Color fundus photograph · 2352 by 1568 pixels
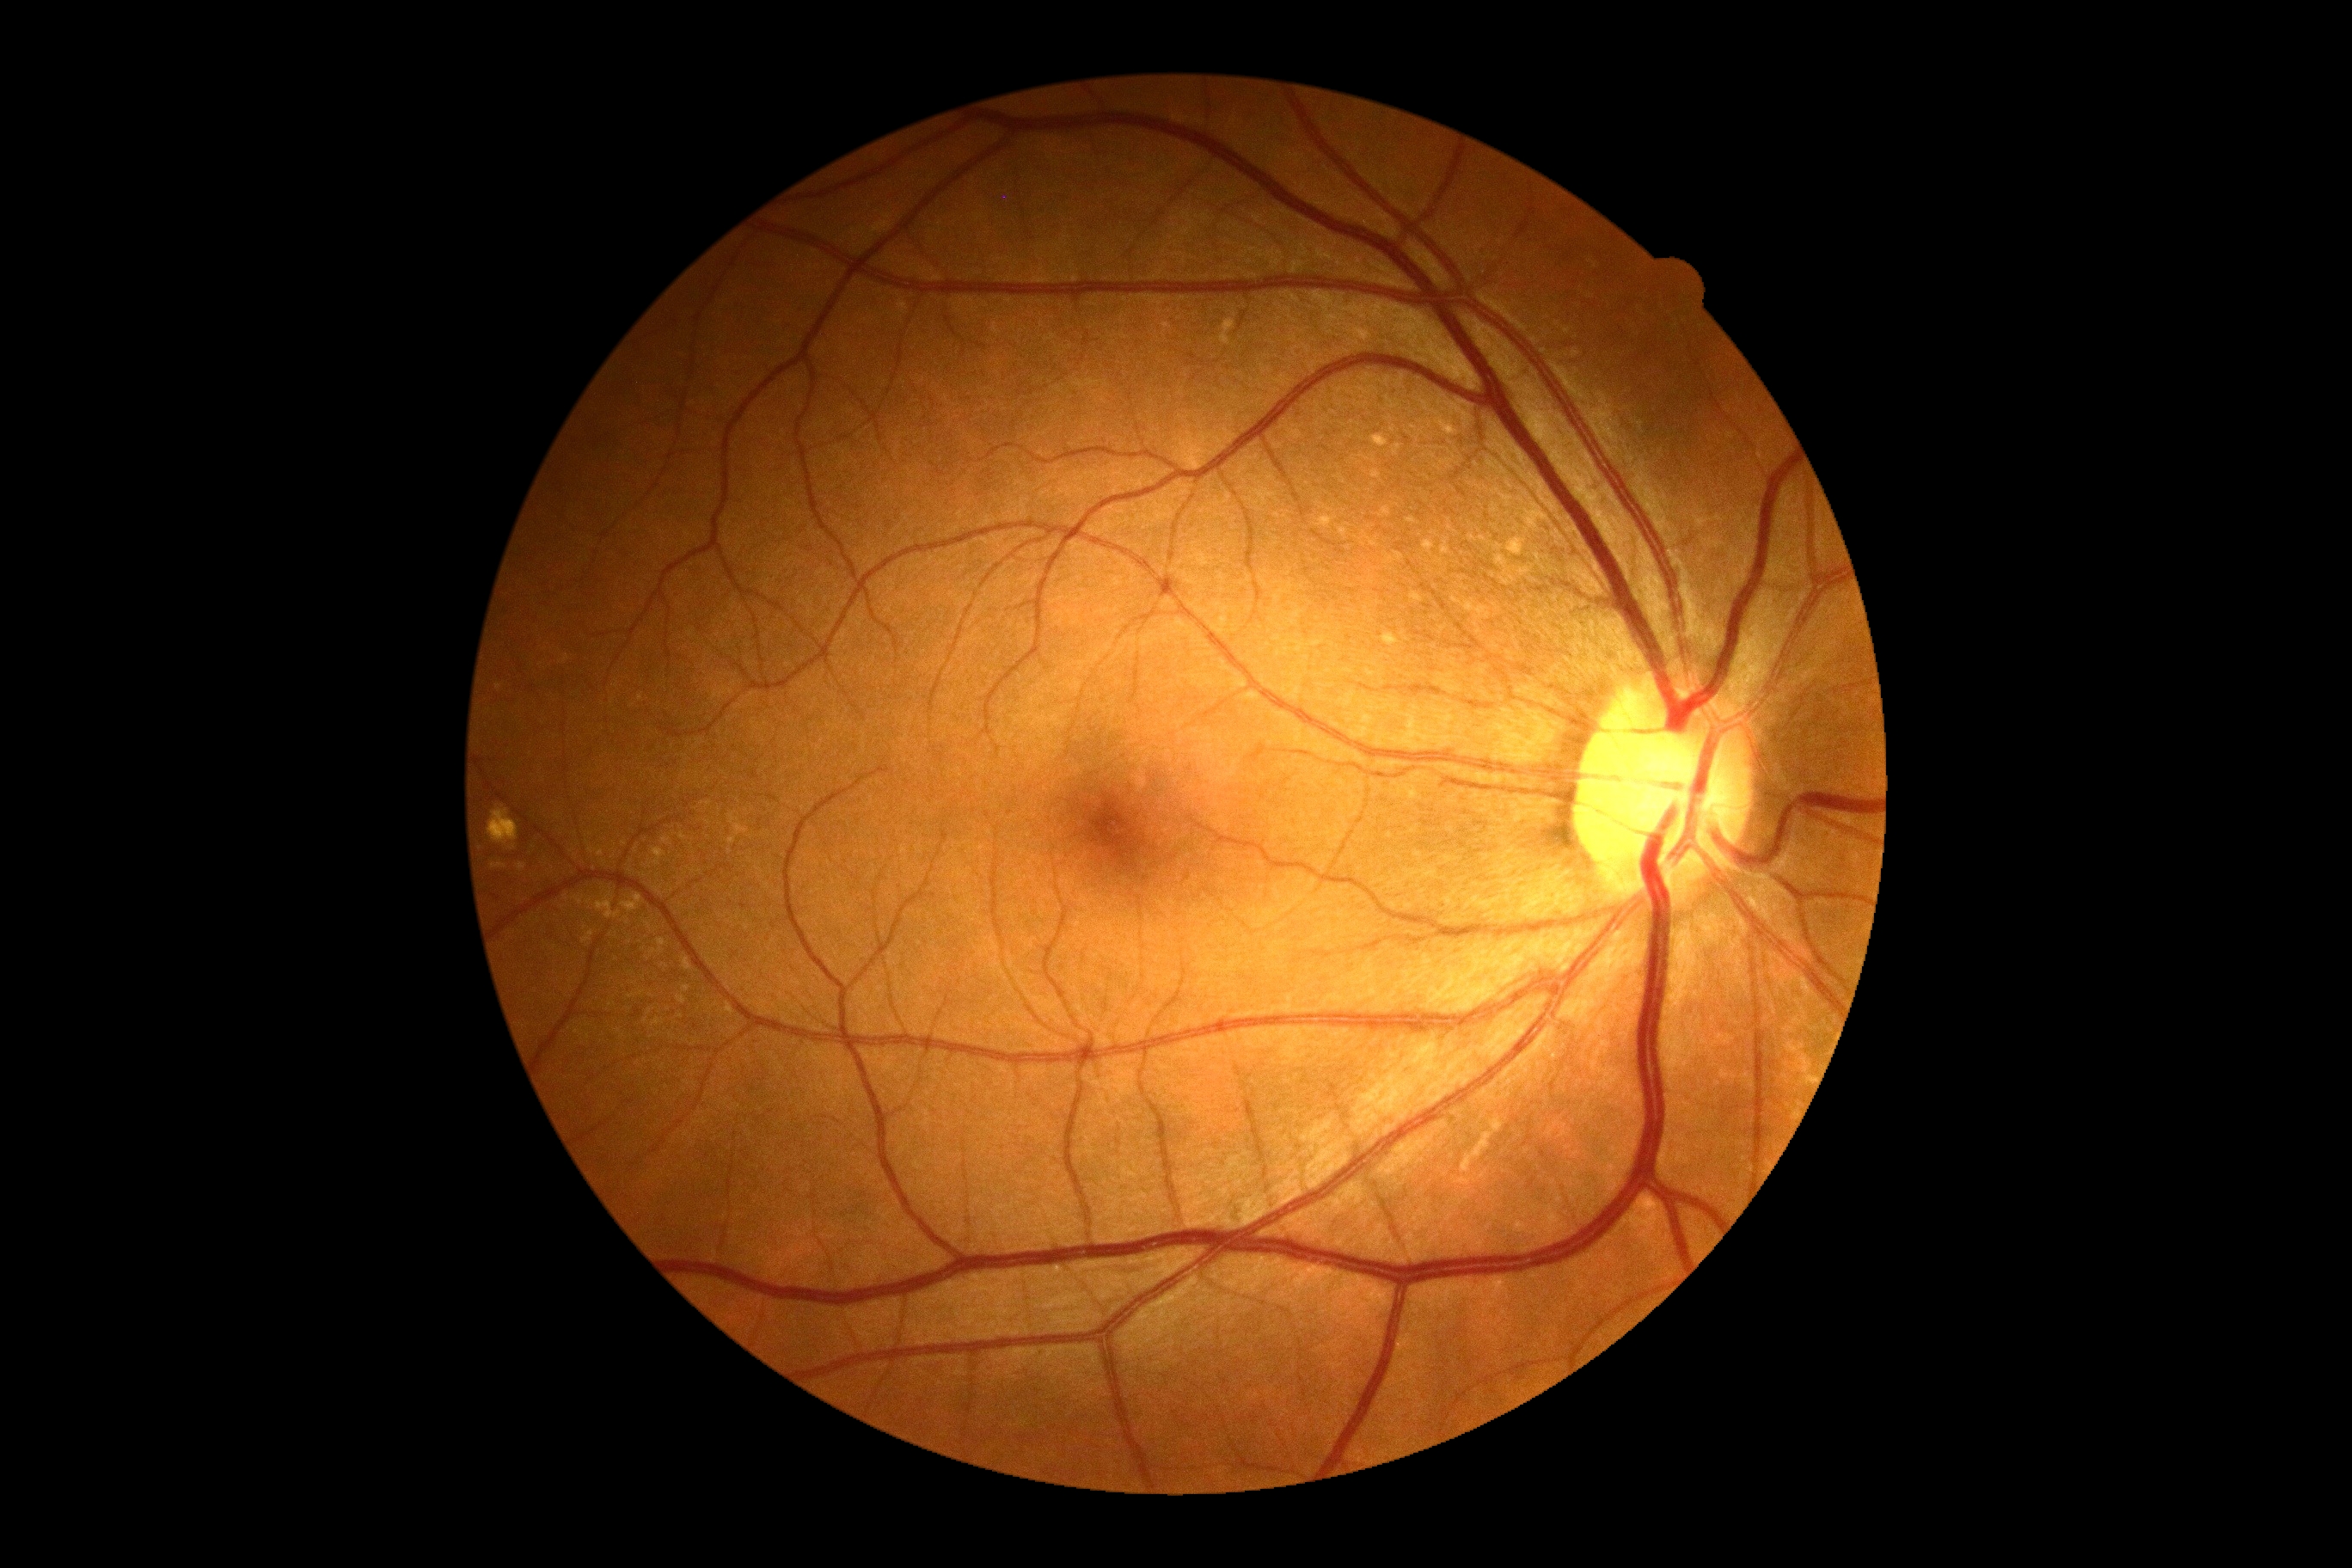

Retinopathy grade: no apparent retinopathy (0).